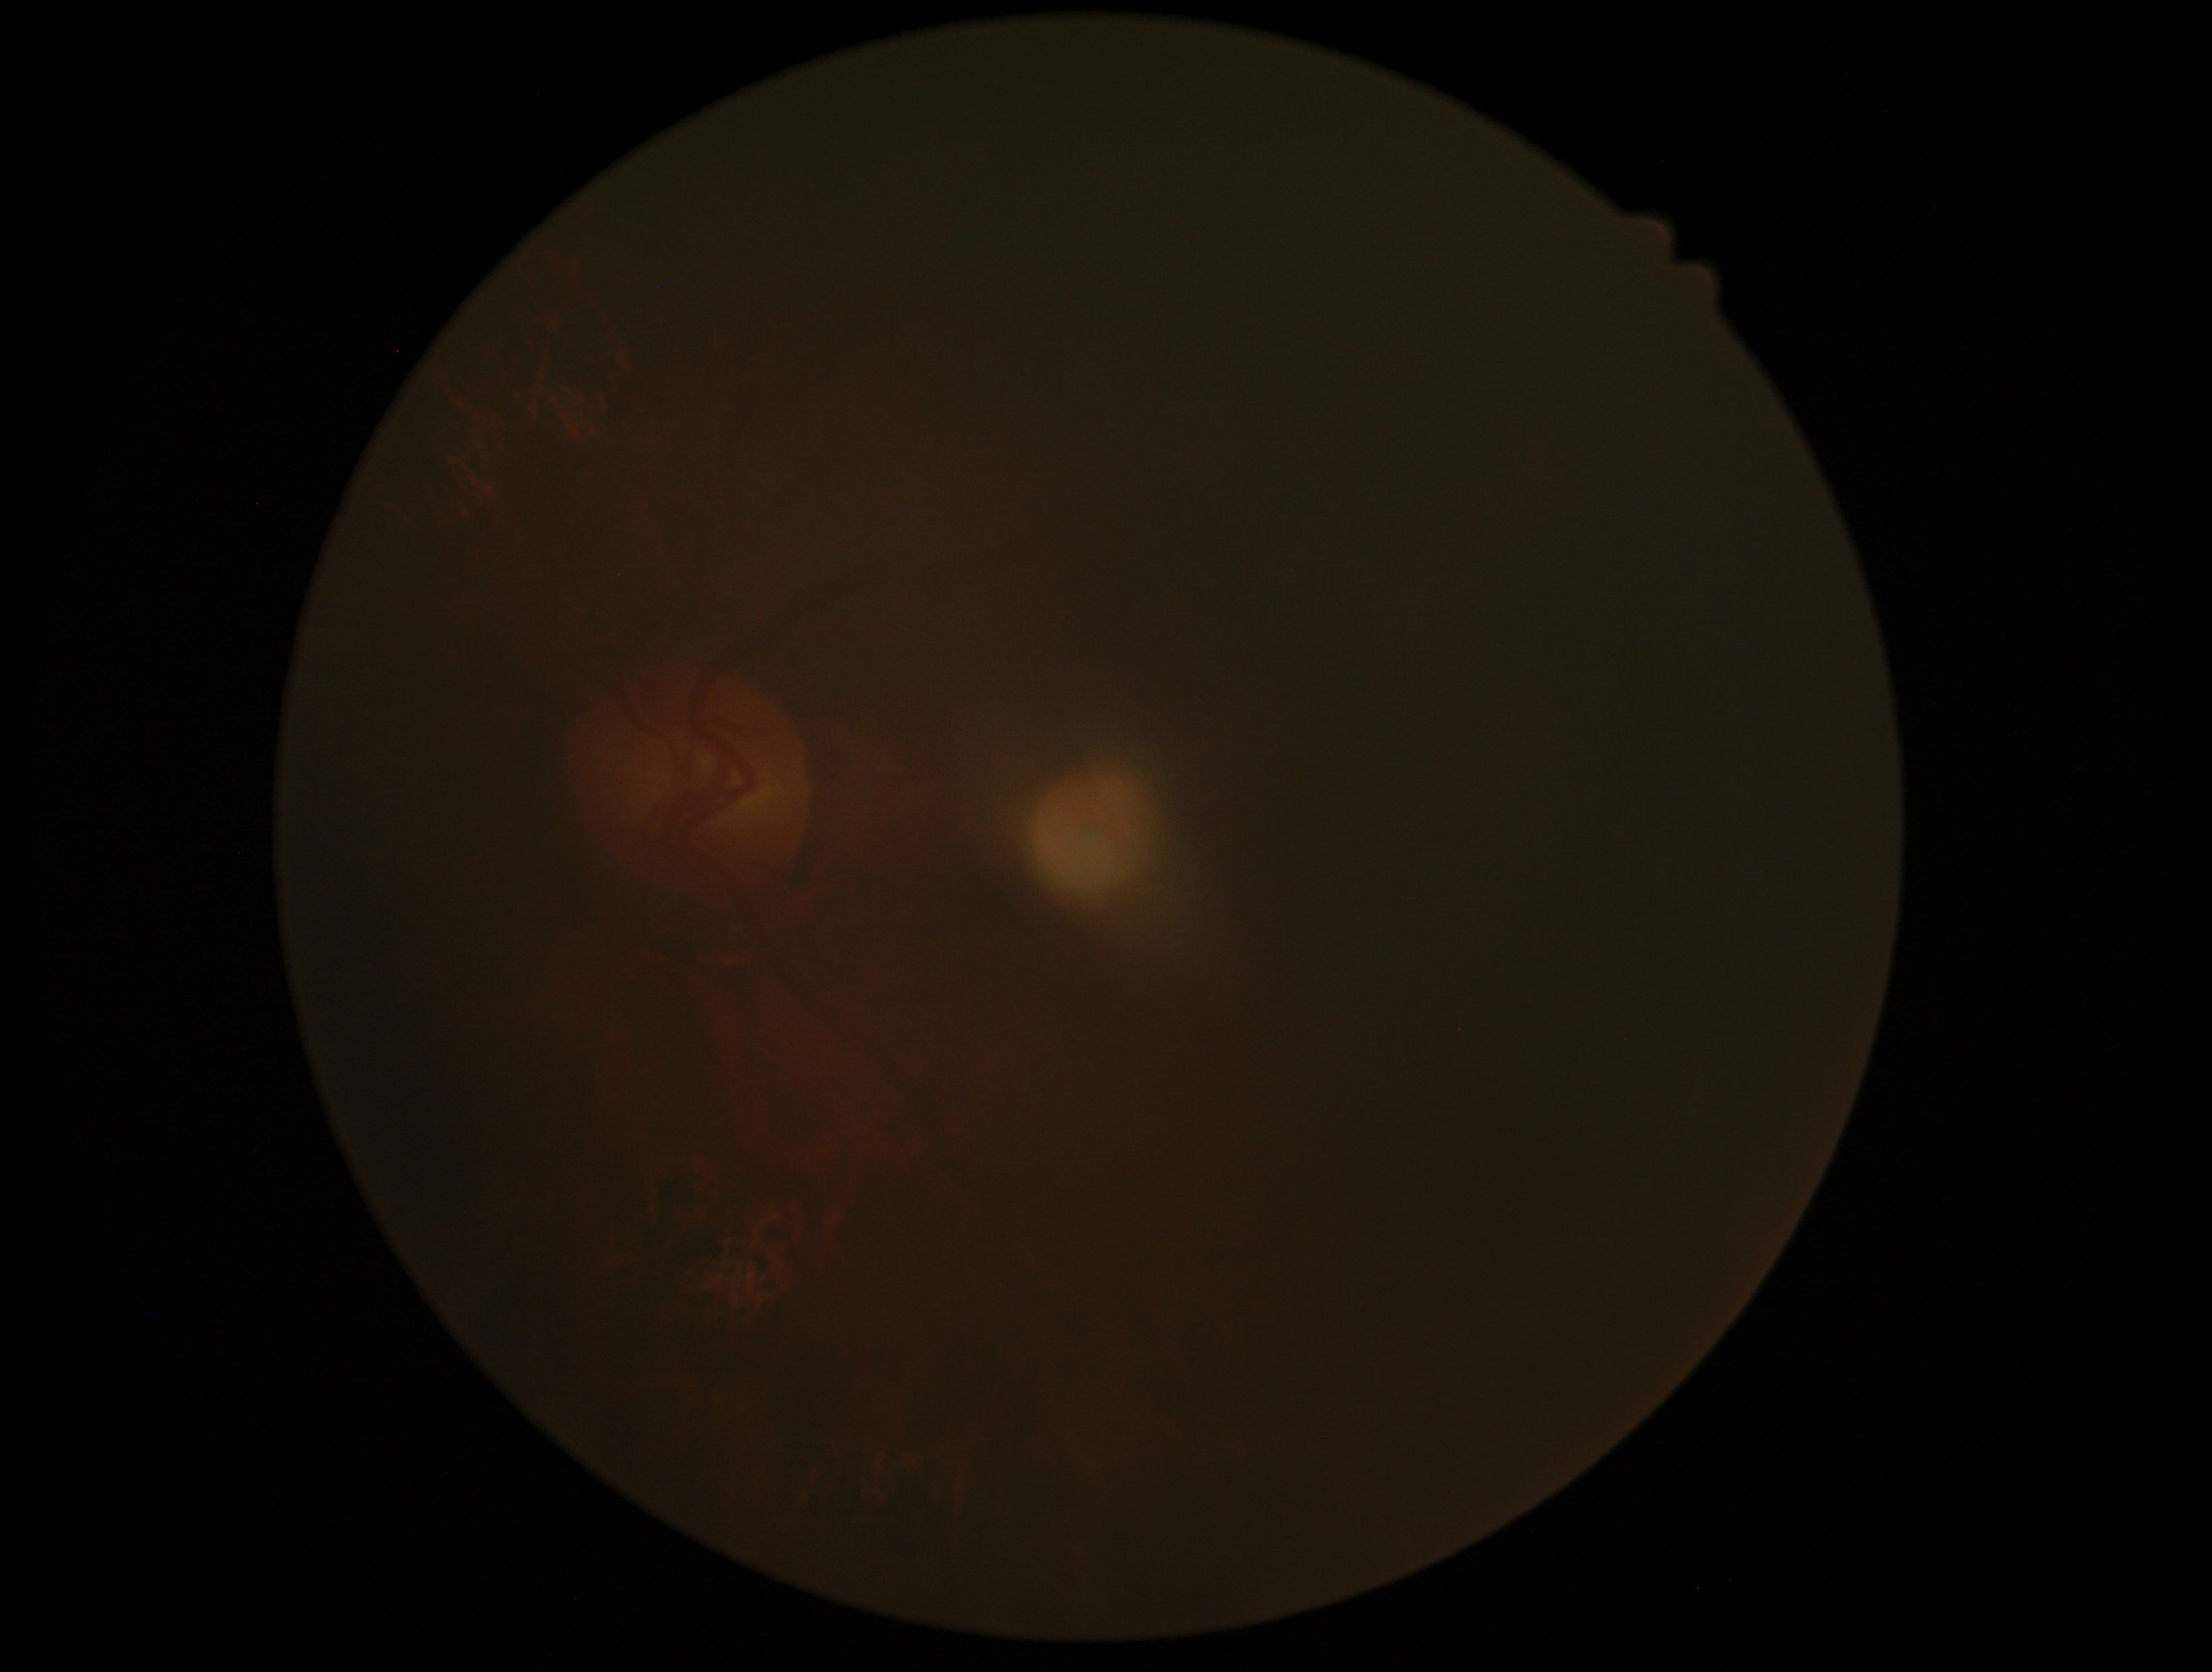
Annotations:
– image quality: insufficient for DR assessment
– diabetic retinopathy severity: ungradable